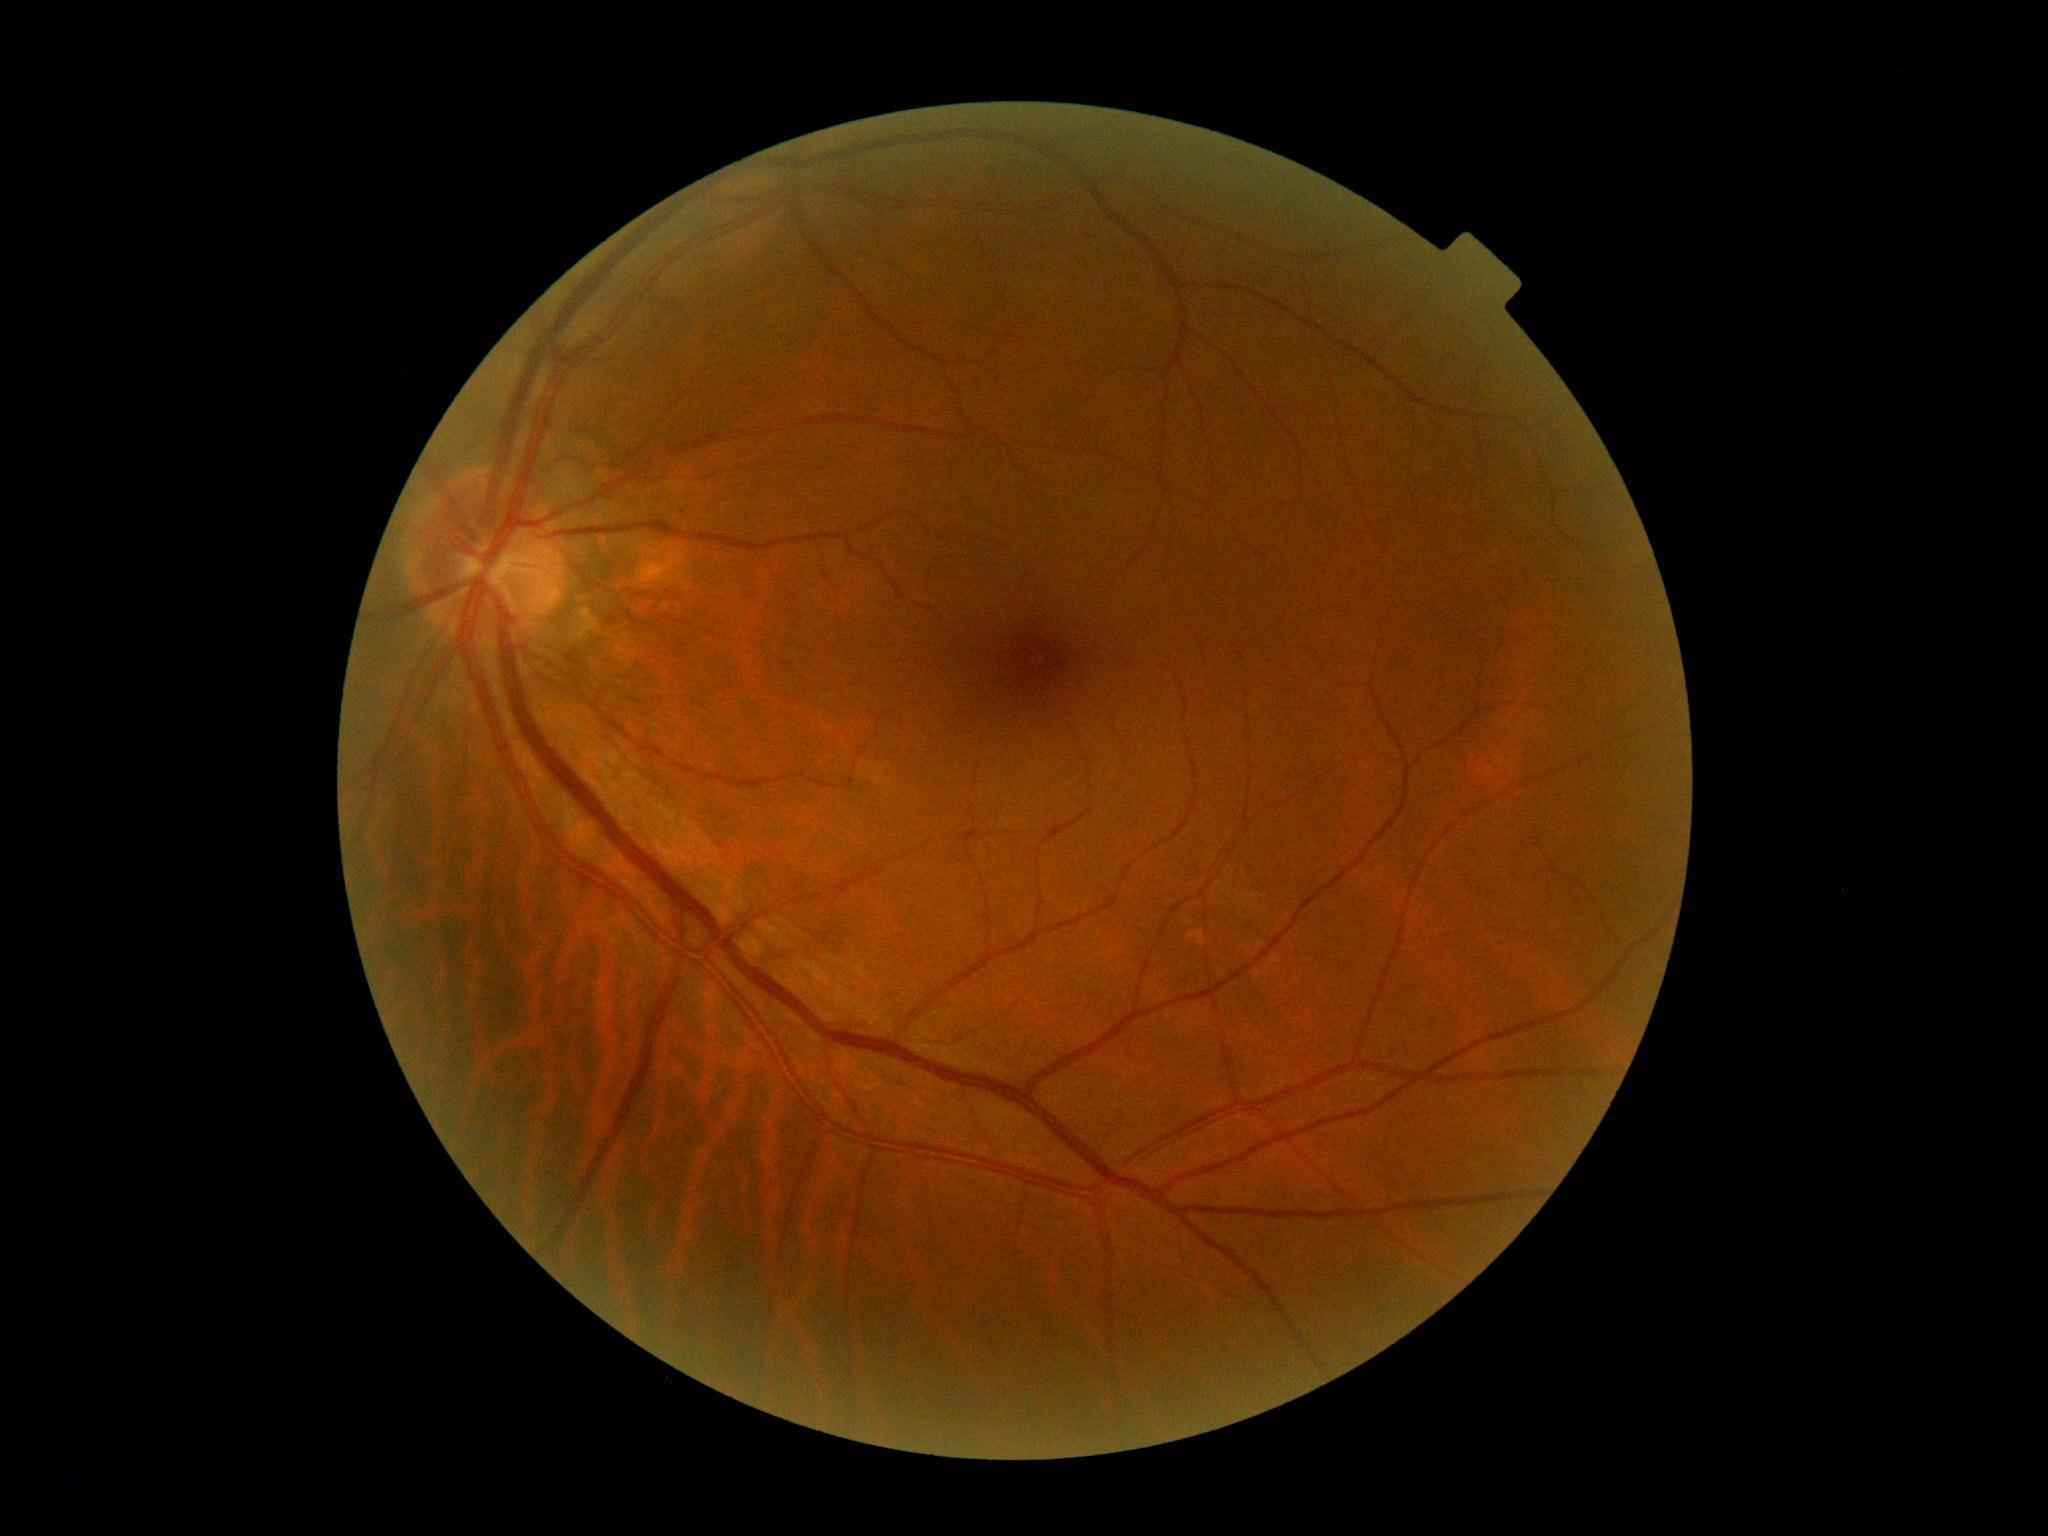 diabetic retinopathy: grade 0.